45° field of view, 848 x 848 pixels, fundus photo, DR severity per modified Davis staging: 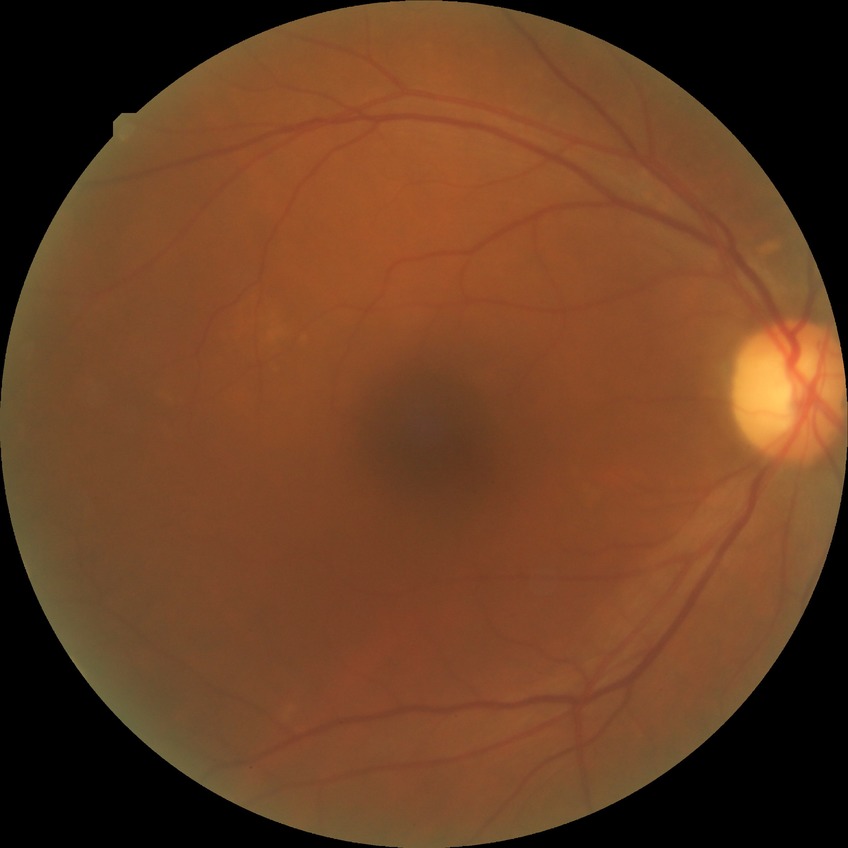

Retinopathy grade is no diabetic retinopathy.